1240 by 1240 pixels; infant wide-field retinal image — 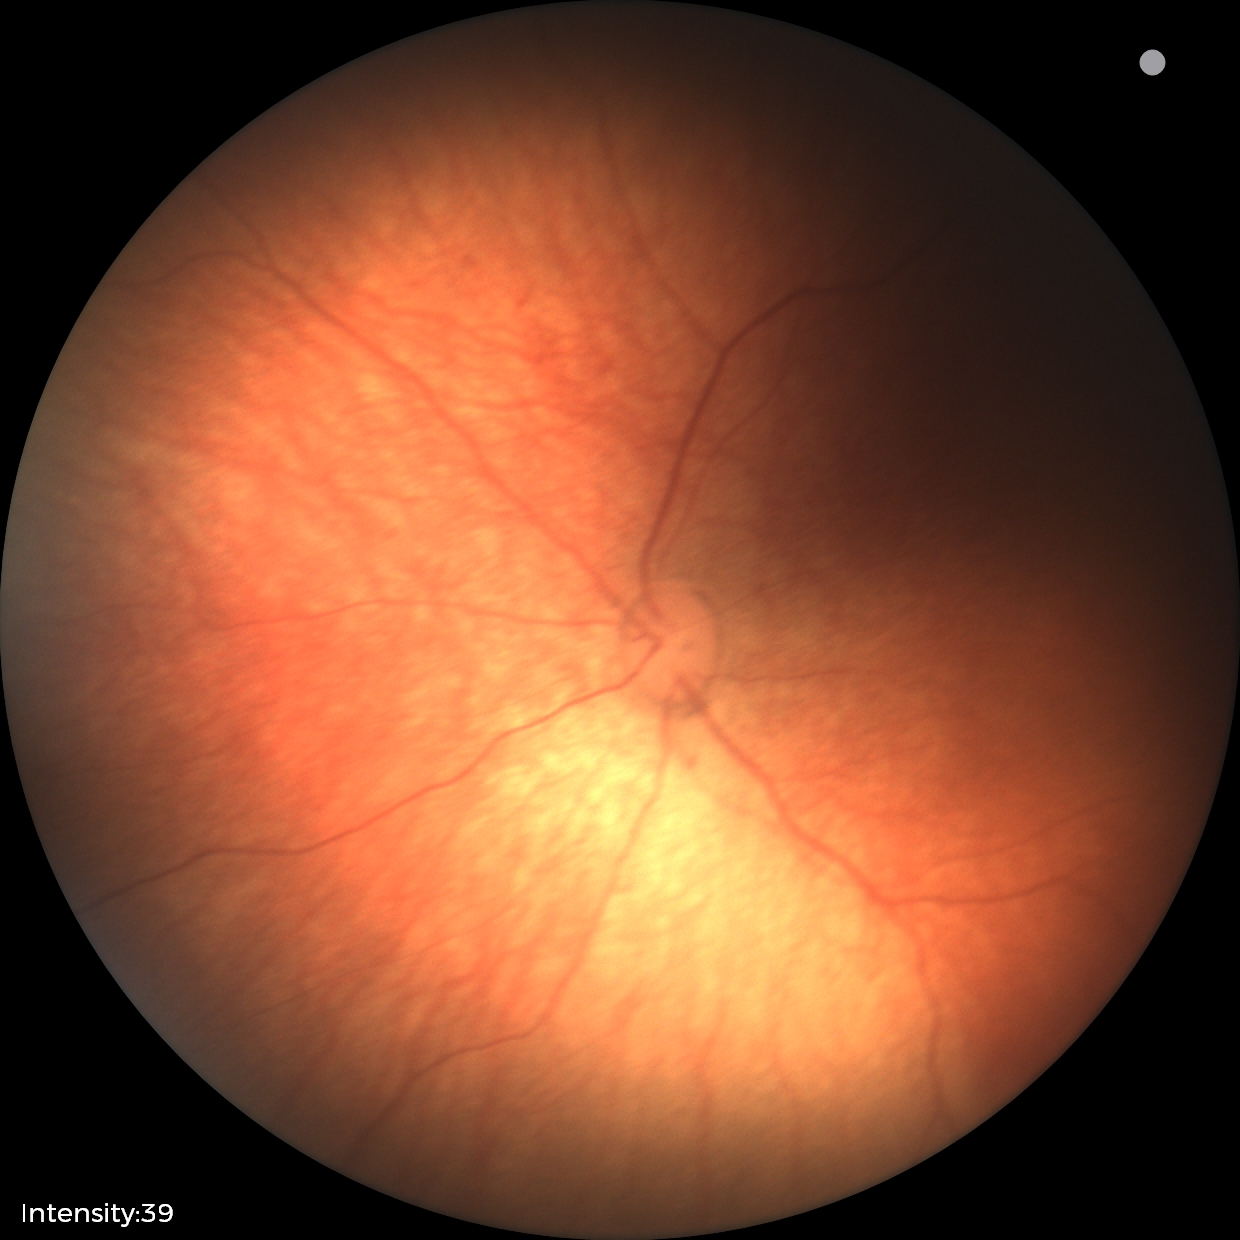

No retinal pathology identified on screening.